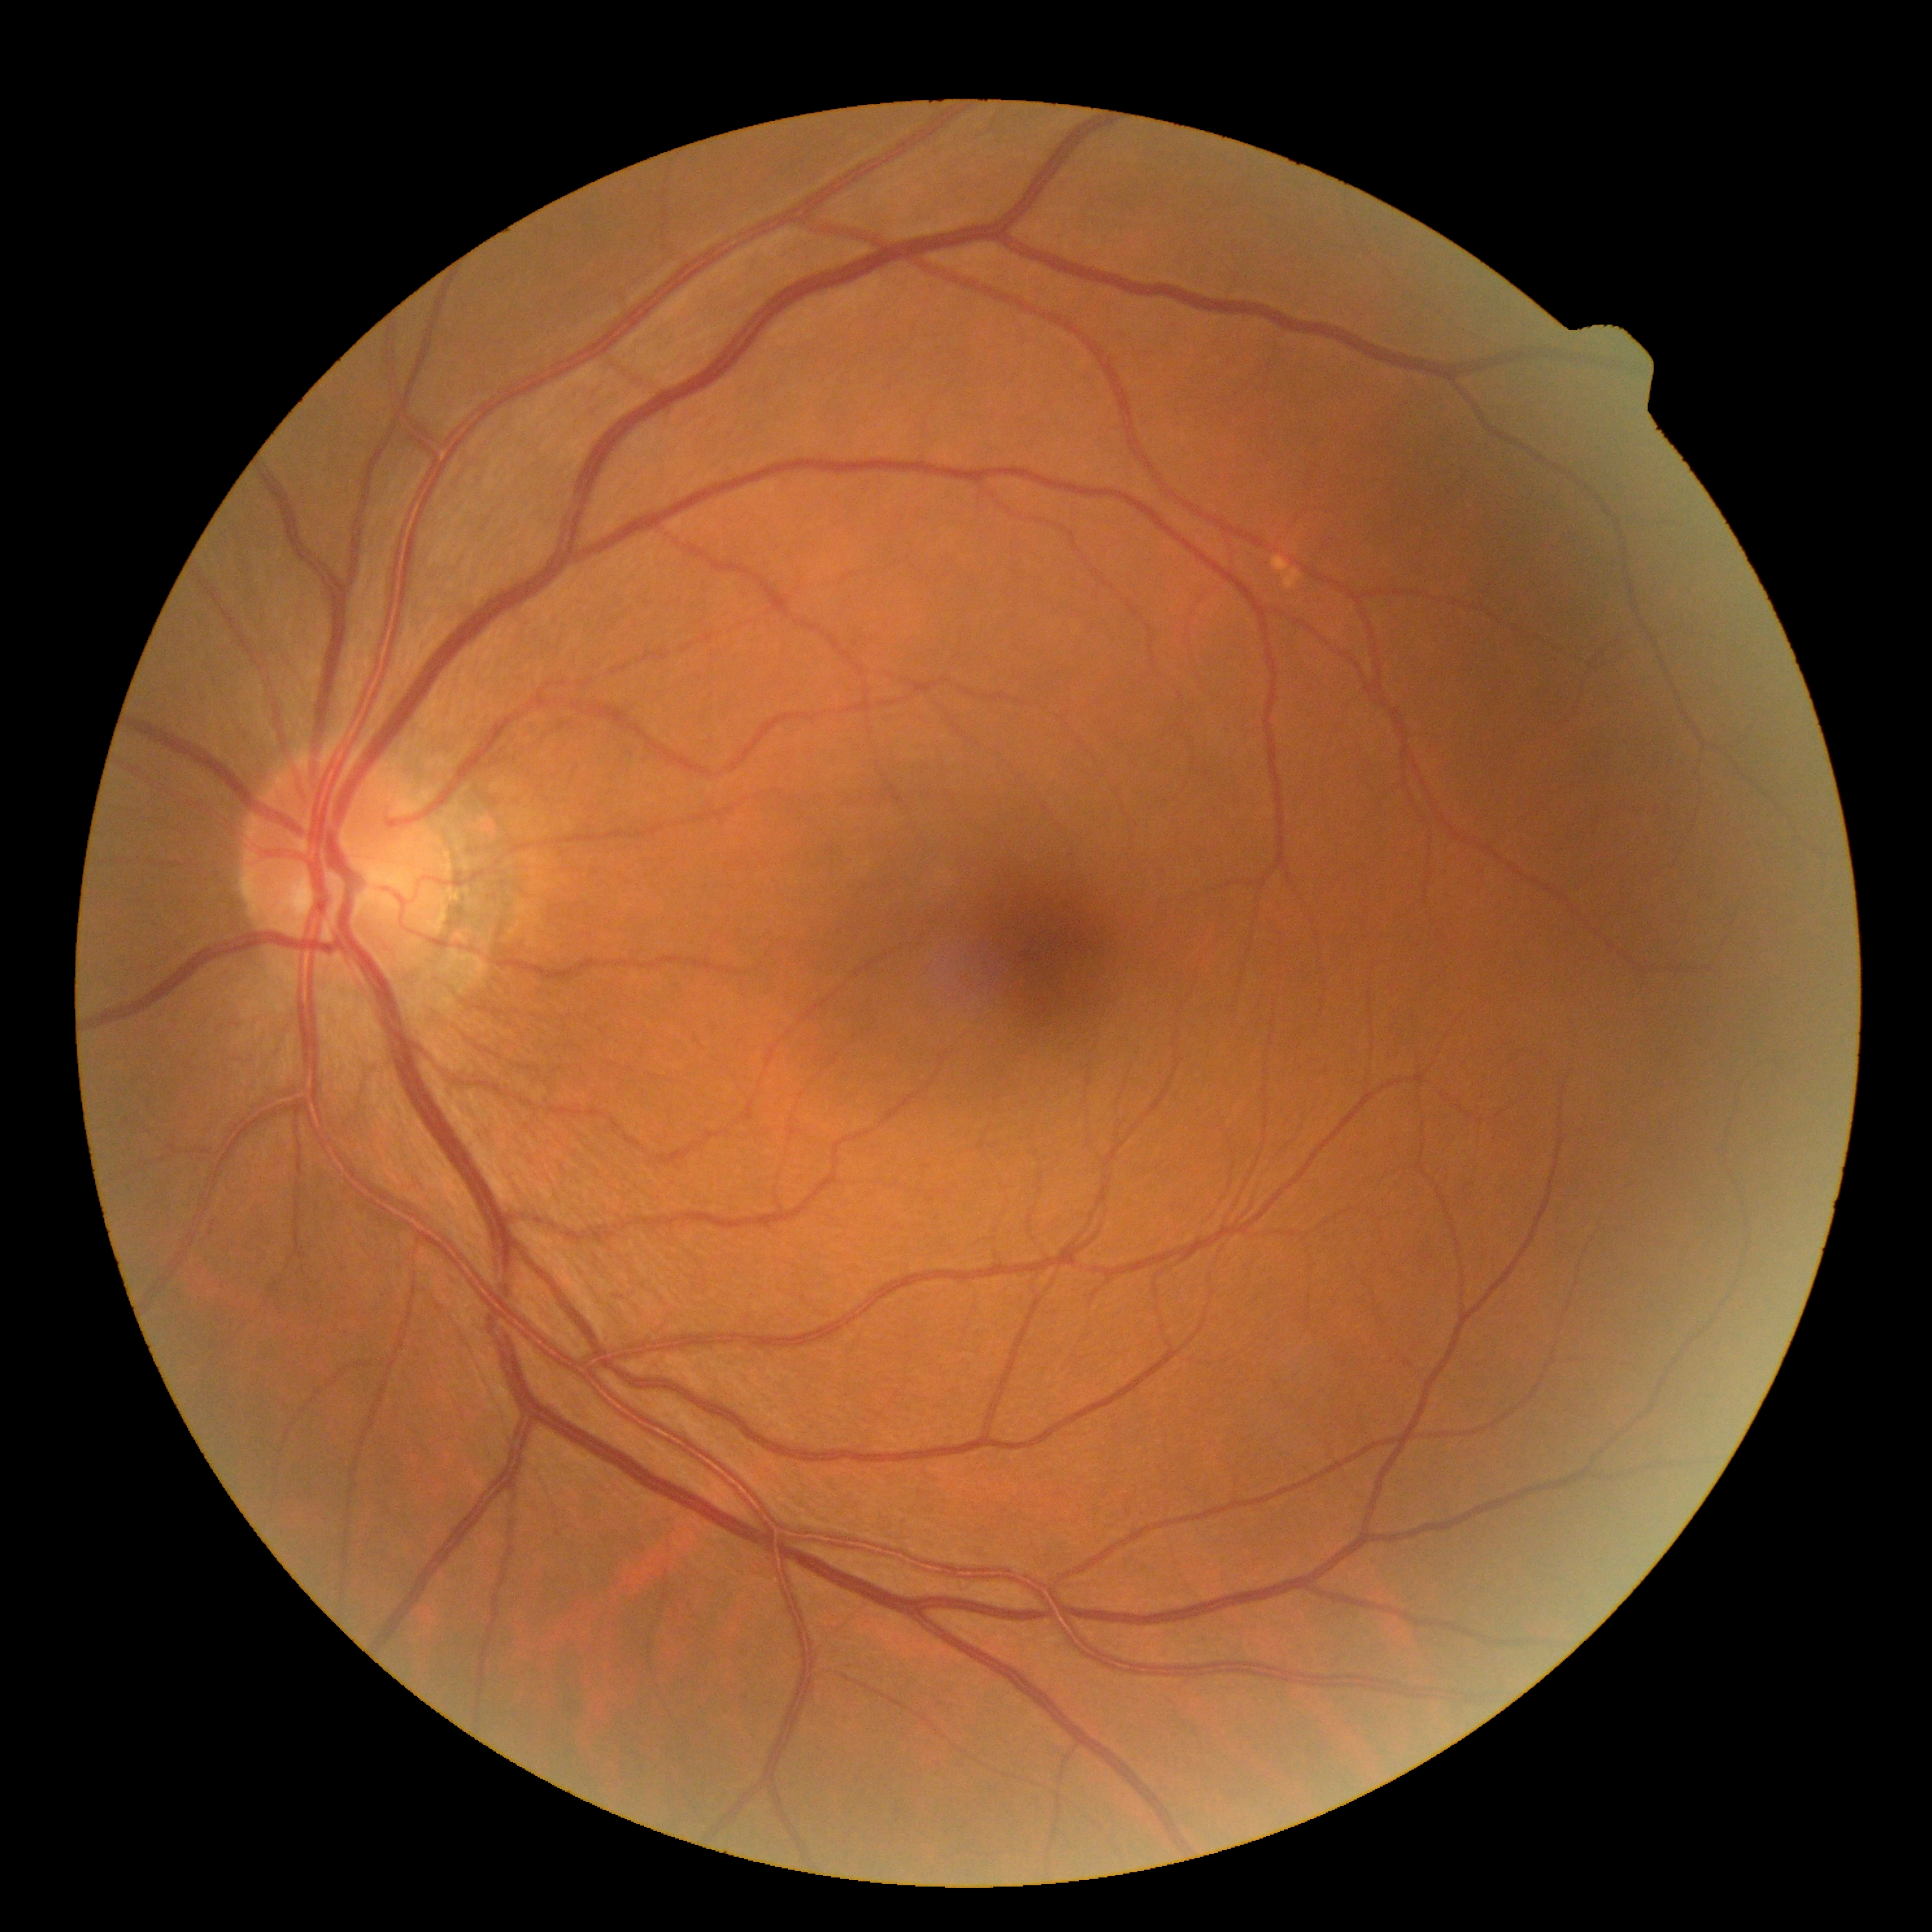

retinopathy grade@0/4.